2212x1659: 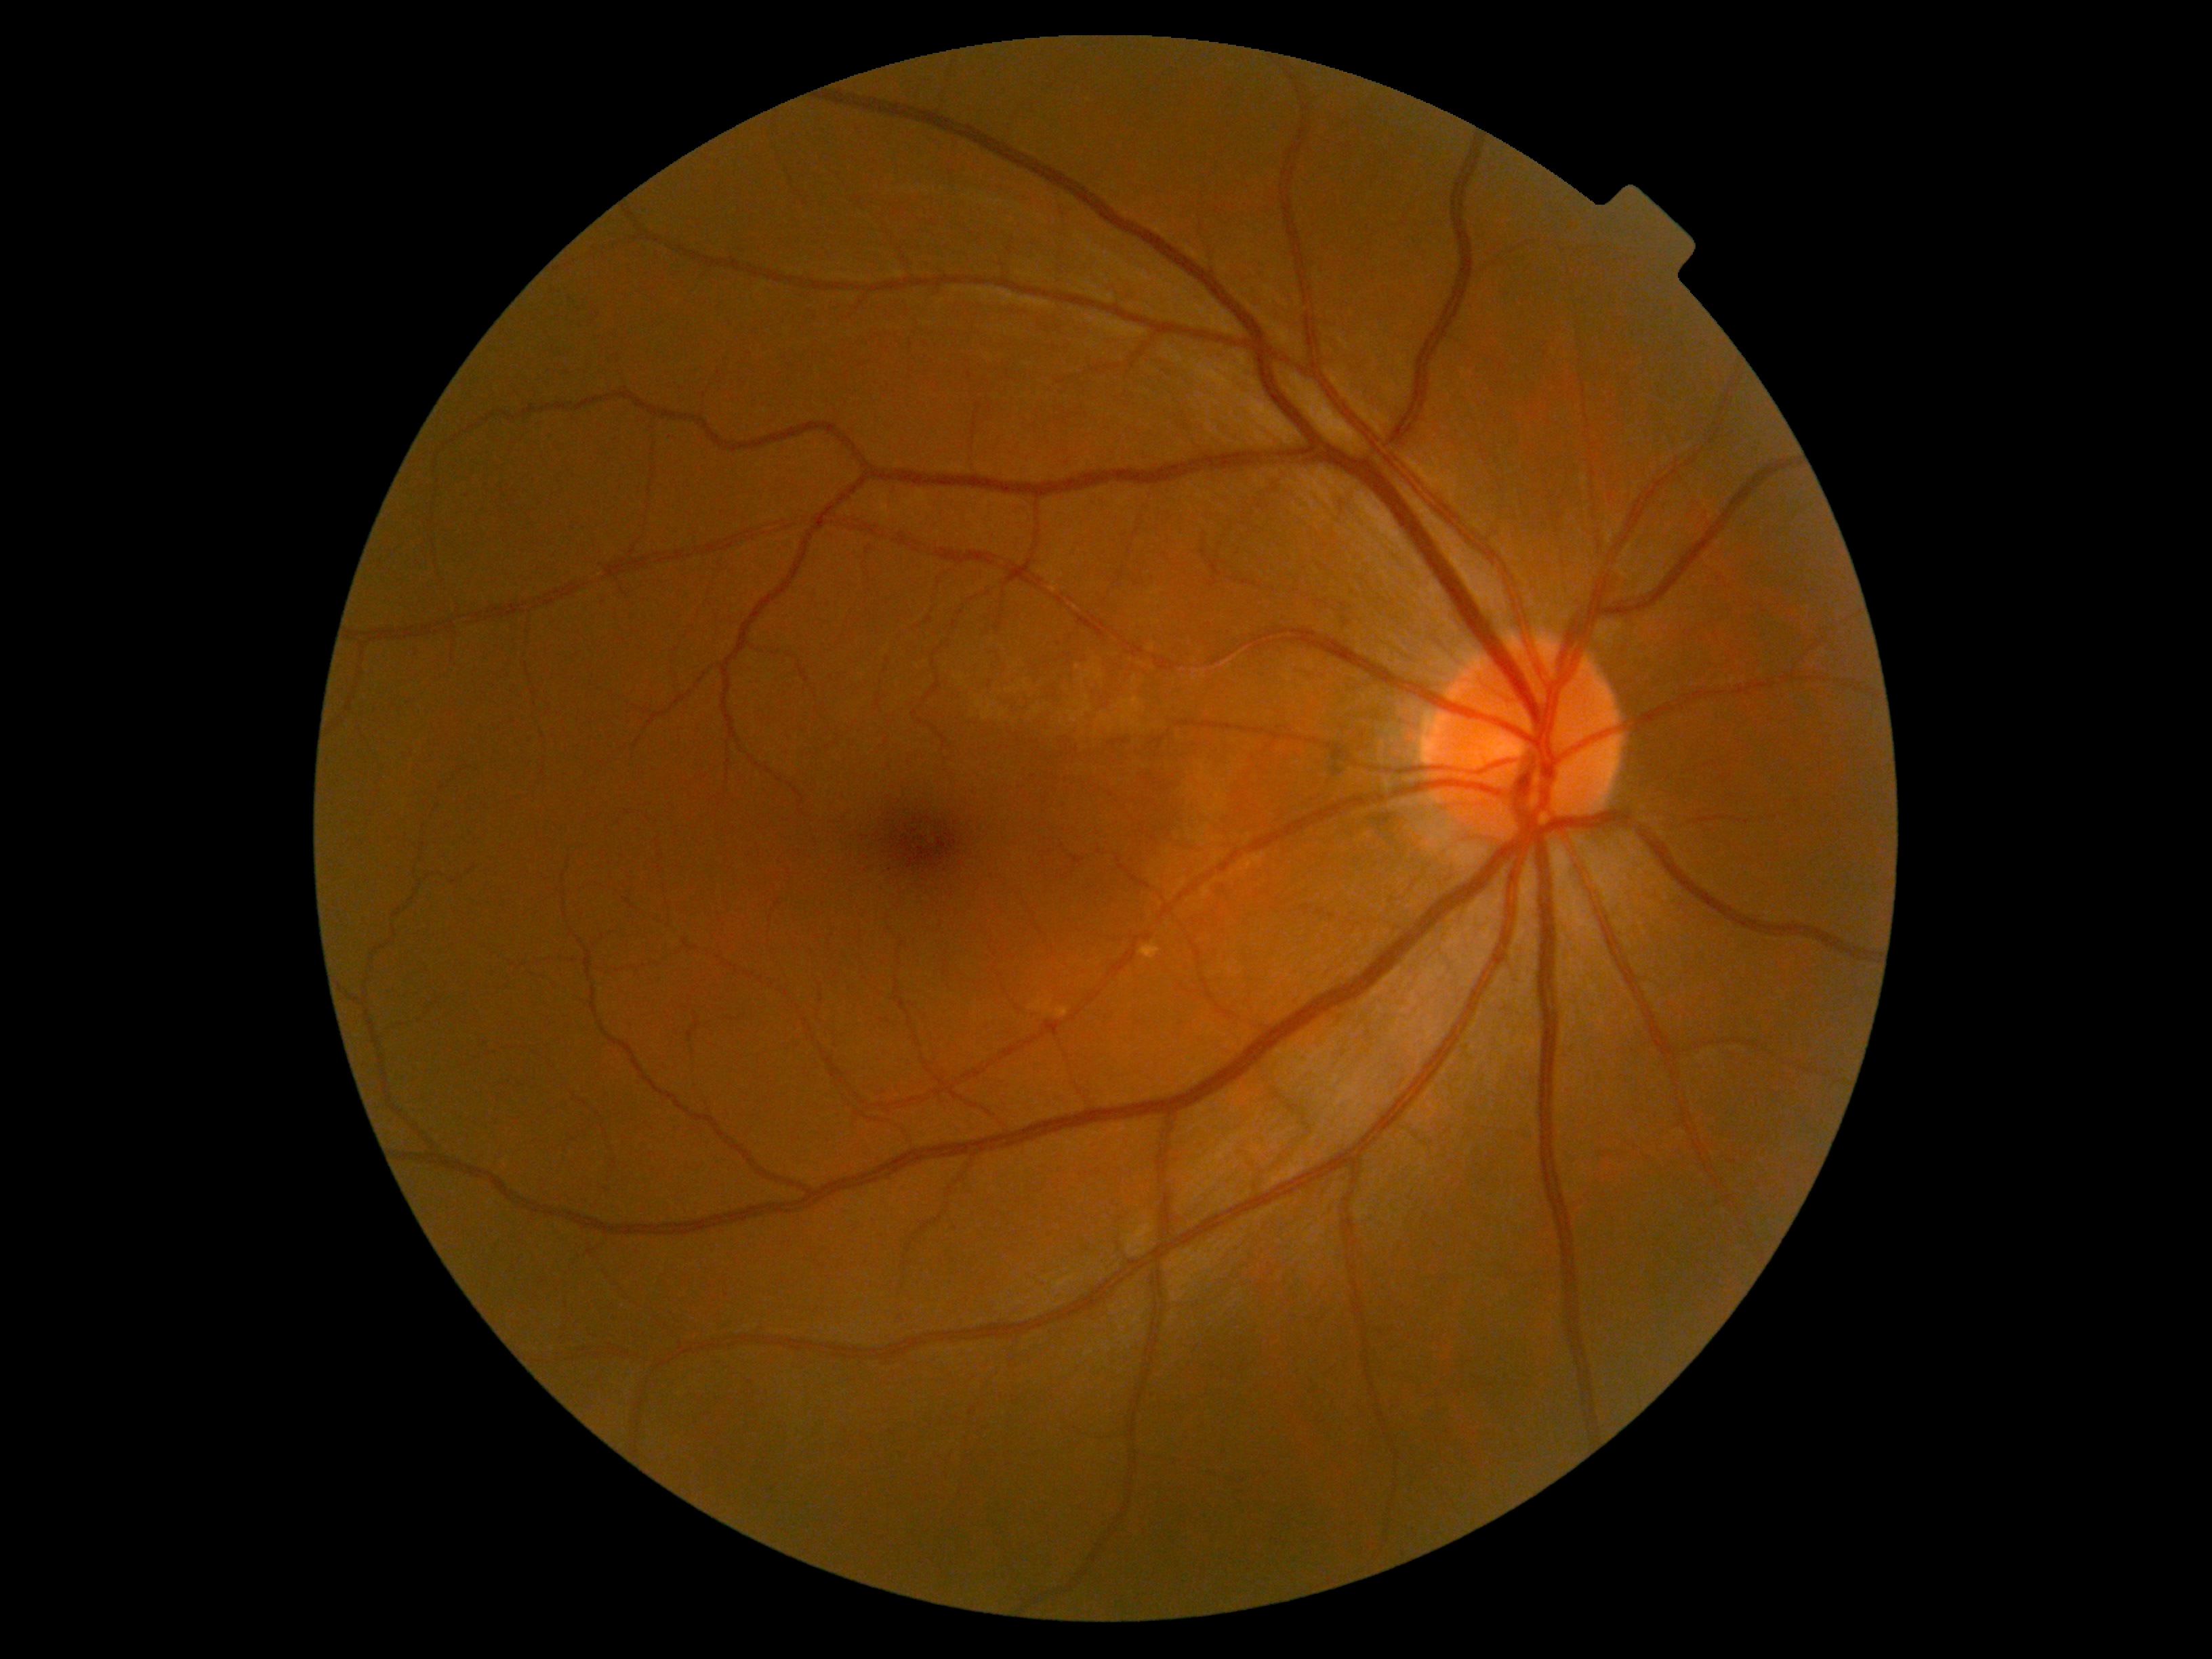 Diabetic retinopathy (DR): 0/4.
No apparent diabetic retinopathy.